Image size 1240x1240; pediatric wide-field fundus photograph: 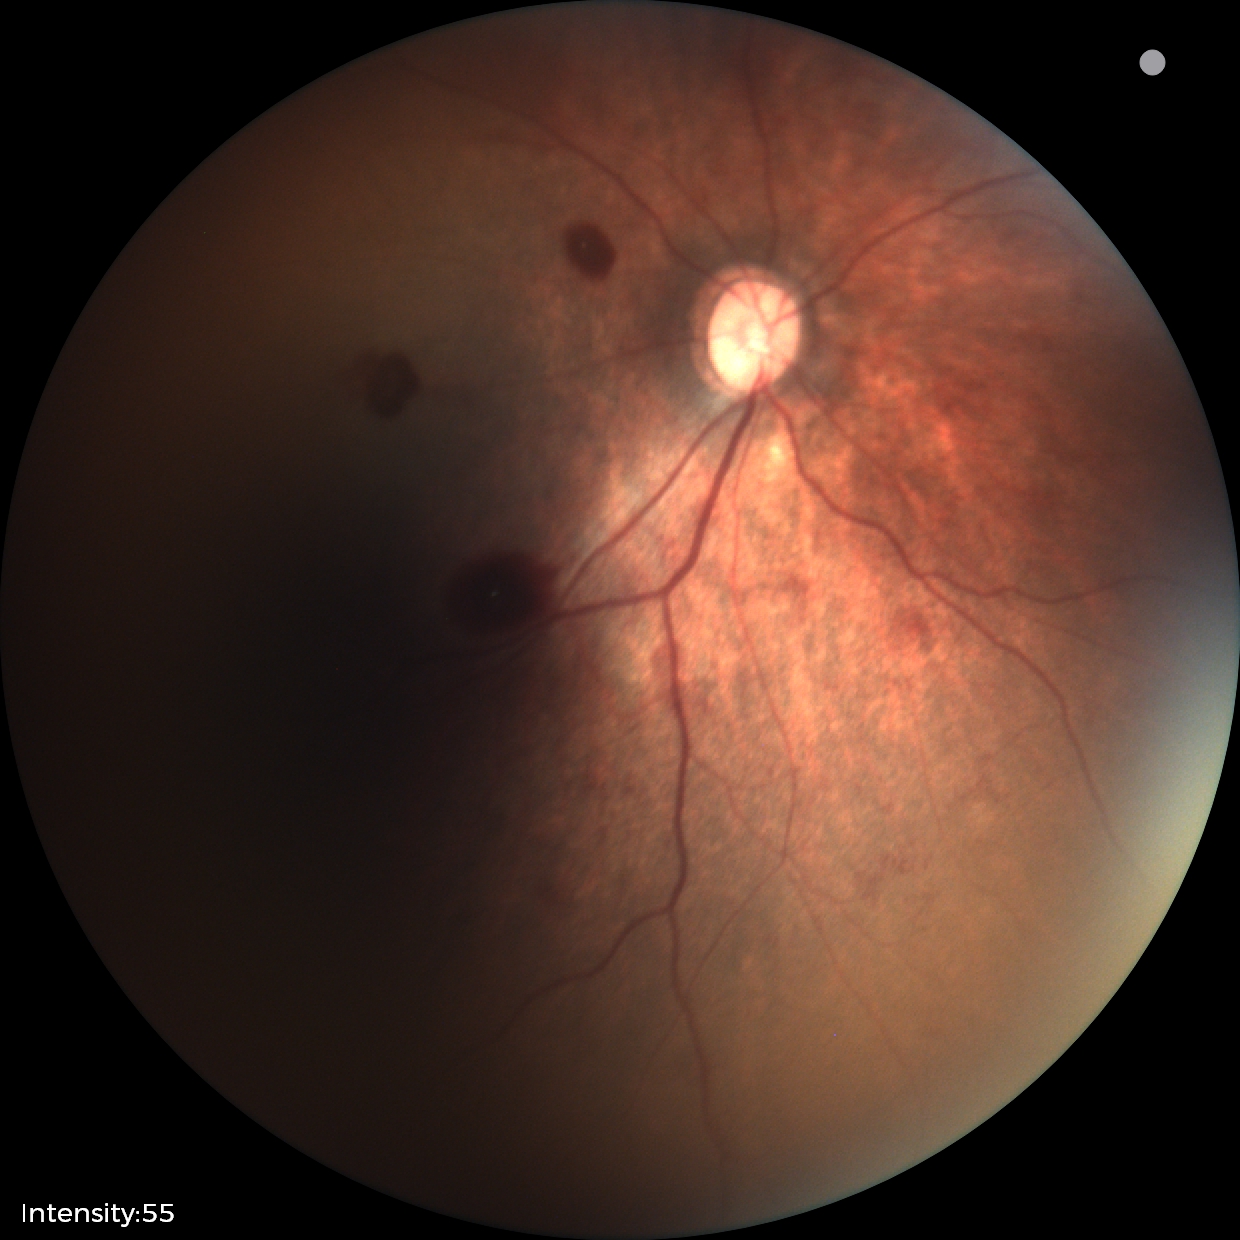

Q: What was the screening finding?
A: retinal hemorrhages